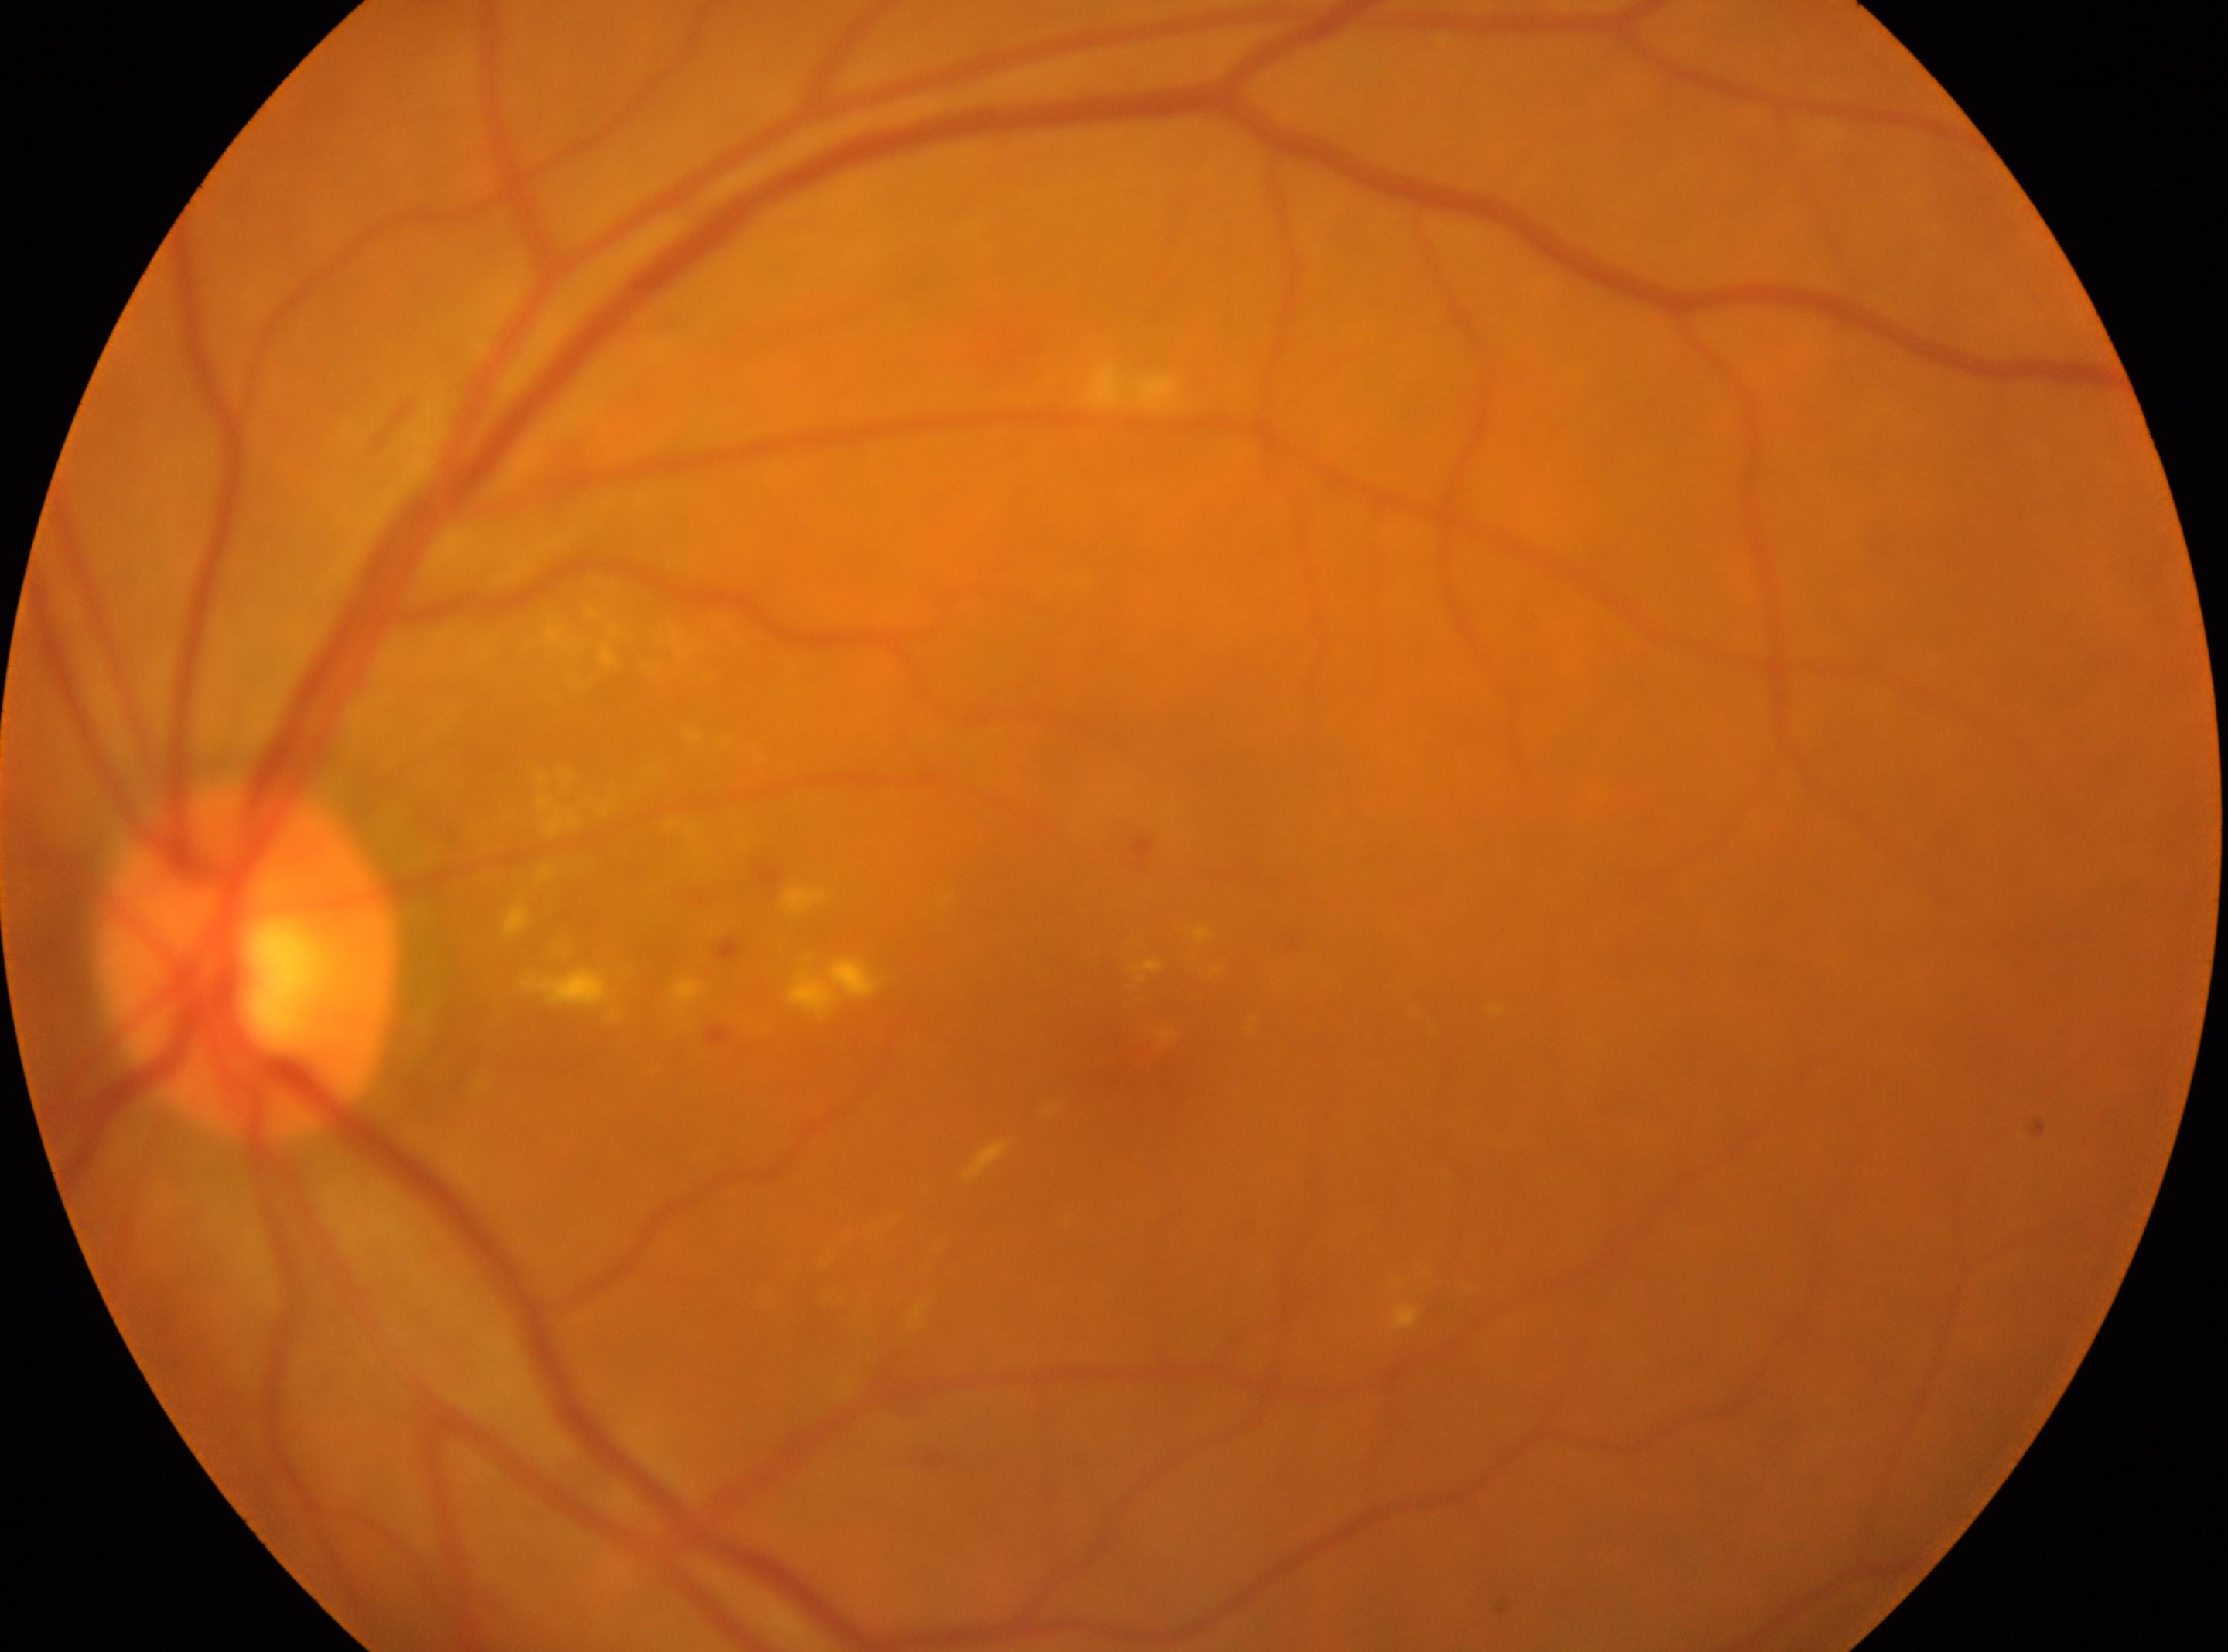

{
  "optic_disc": "x=246, y=962",
  "dr_grade": "2 (moderate NPDR)",
  "eye": "the left eye",
  "fovea": "x=1142, y=1033"
}